Fundus photo, 240 x 240 pixels.
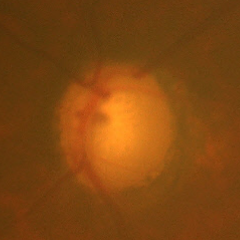

Q: Is glaucoma present?
A: Advanced glaucoma. Defined as near-total cupping of the optic nerve head, with or without severe visual field loss within the central 10 degrees of fixation.